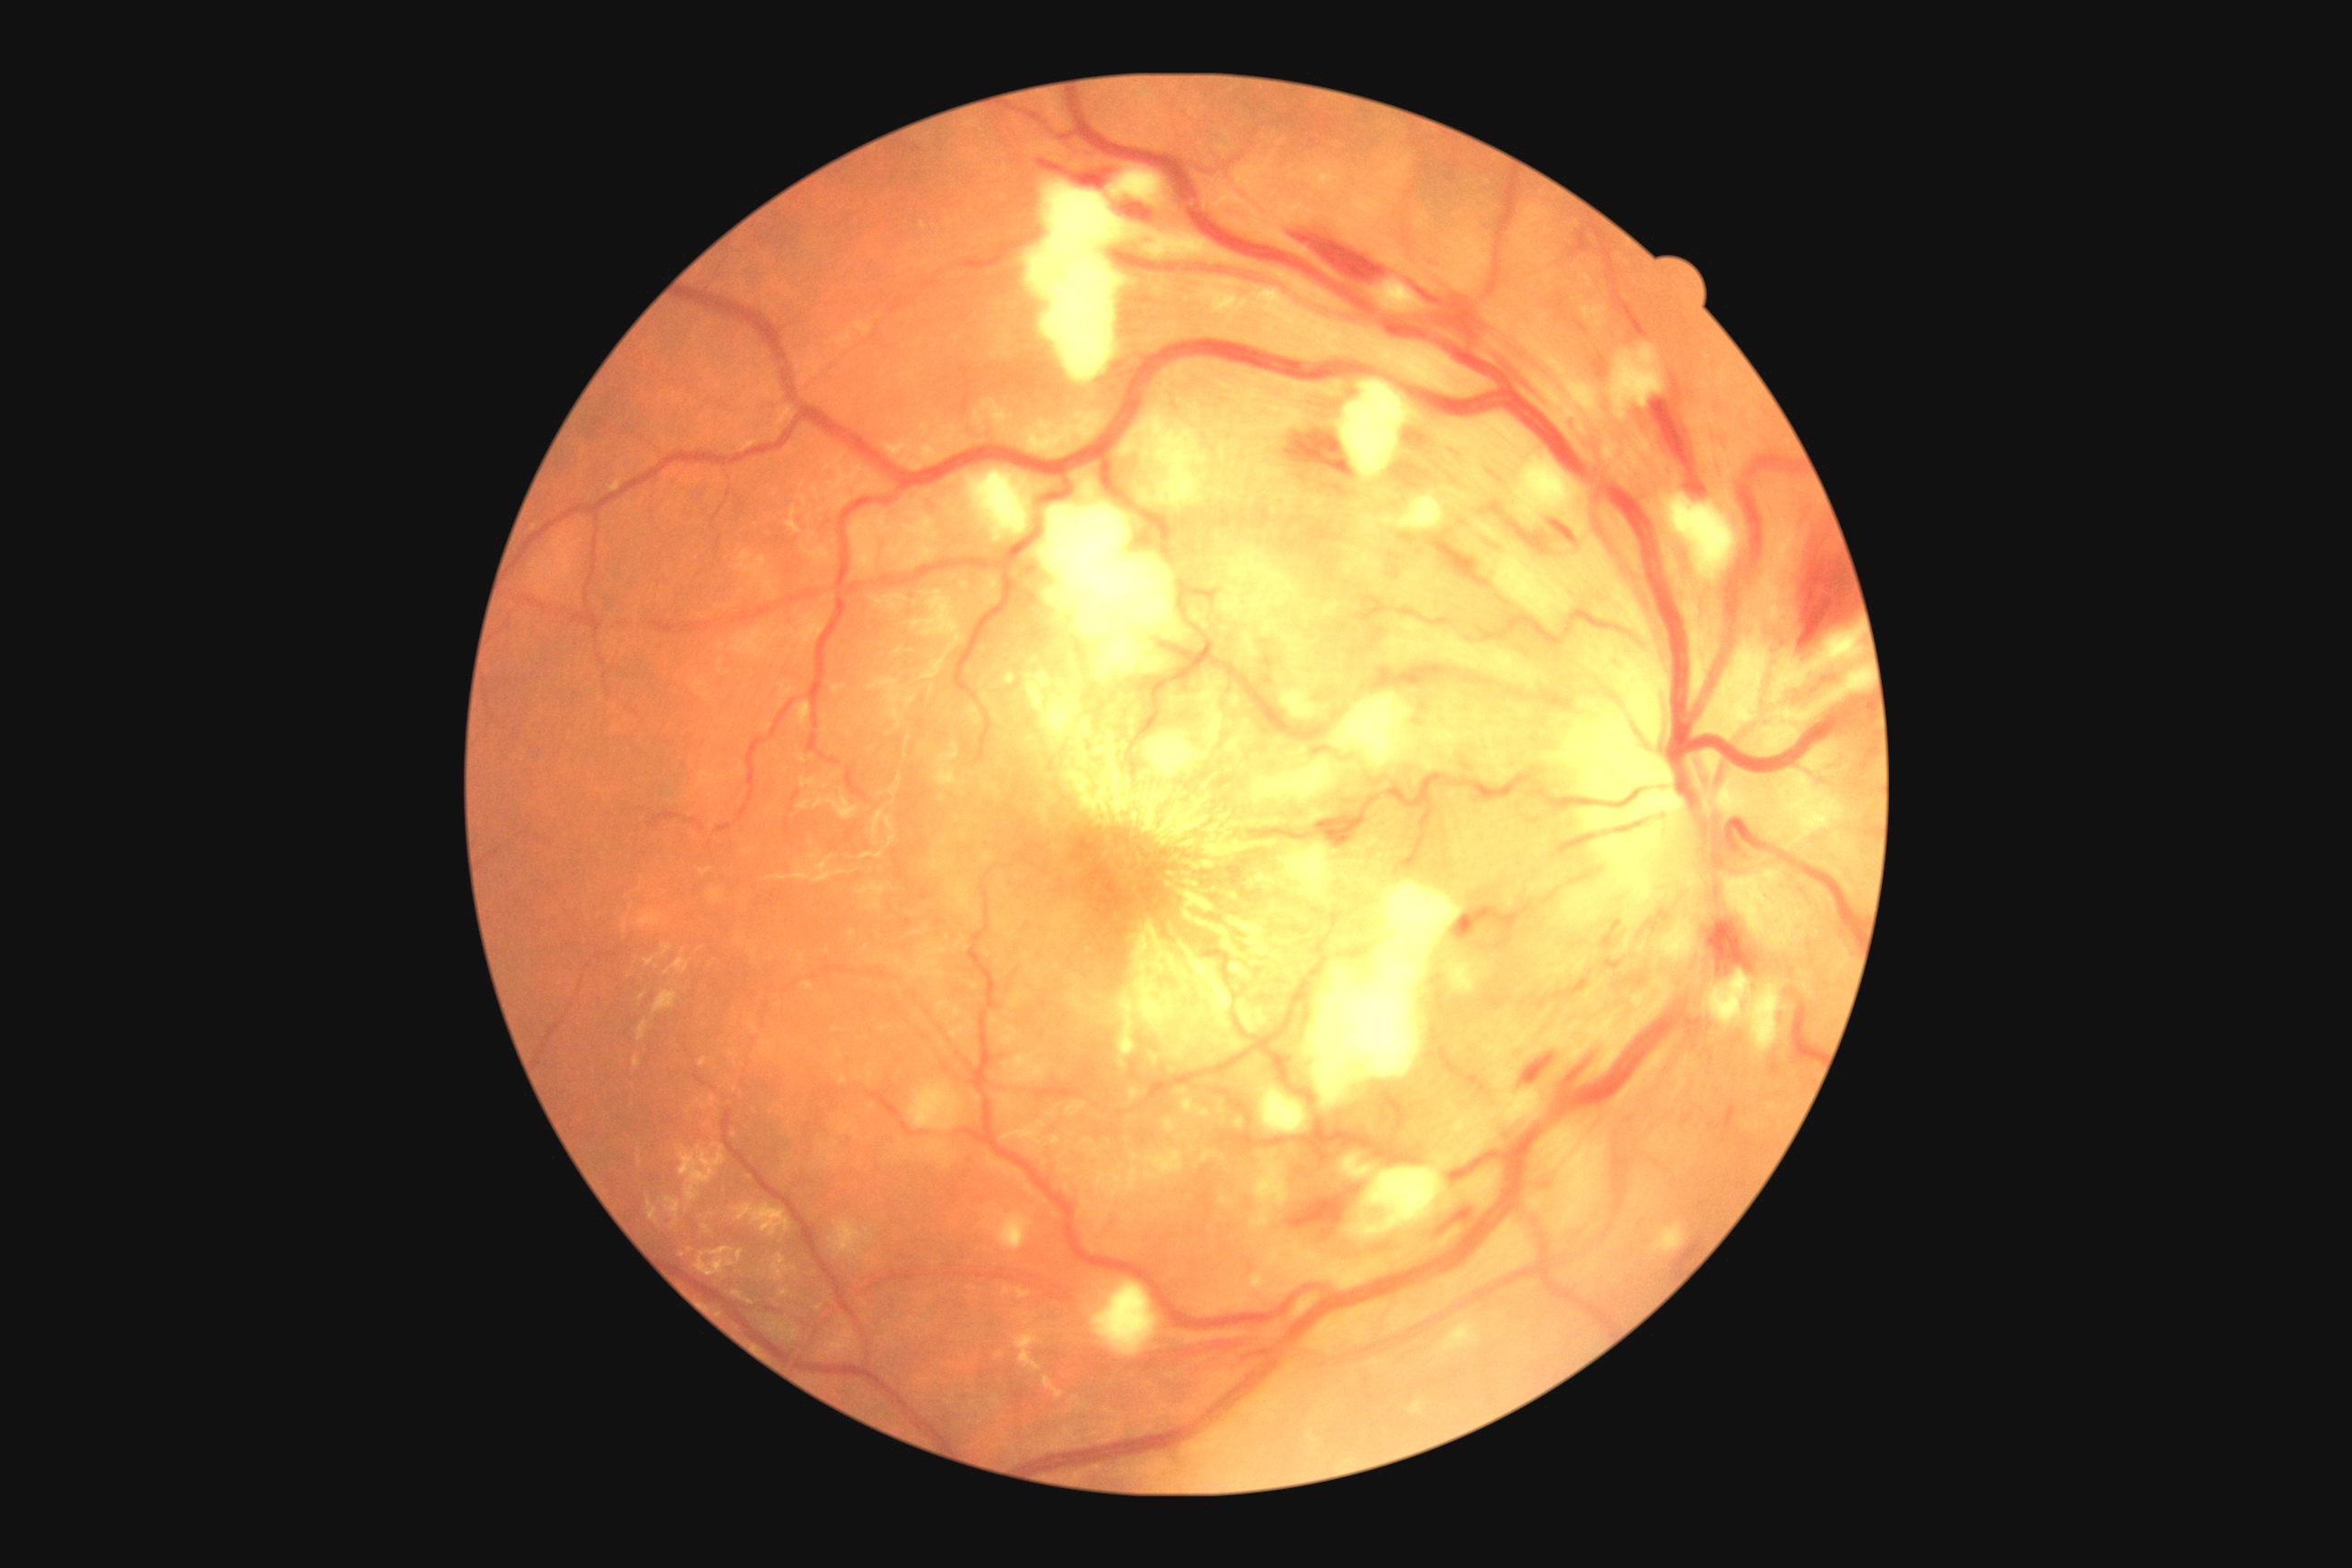
{"dr_category": "non-proliferative diabetic retinopathy", "dr_grade": "grade 2"}